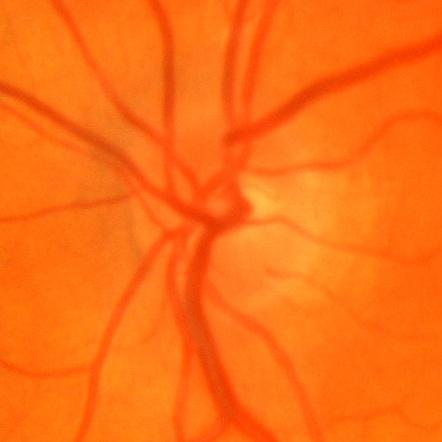

Impression = no glaucomatous findings.